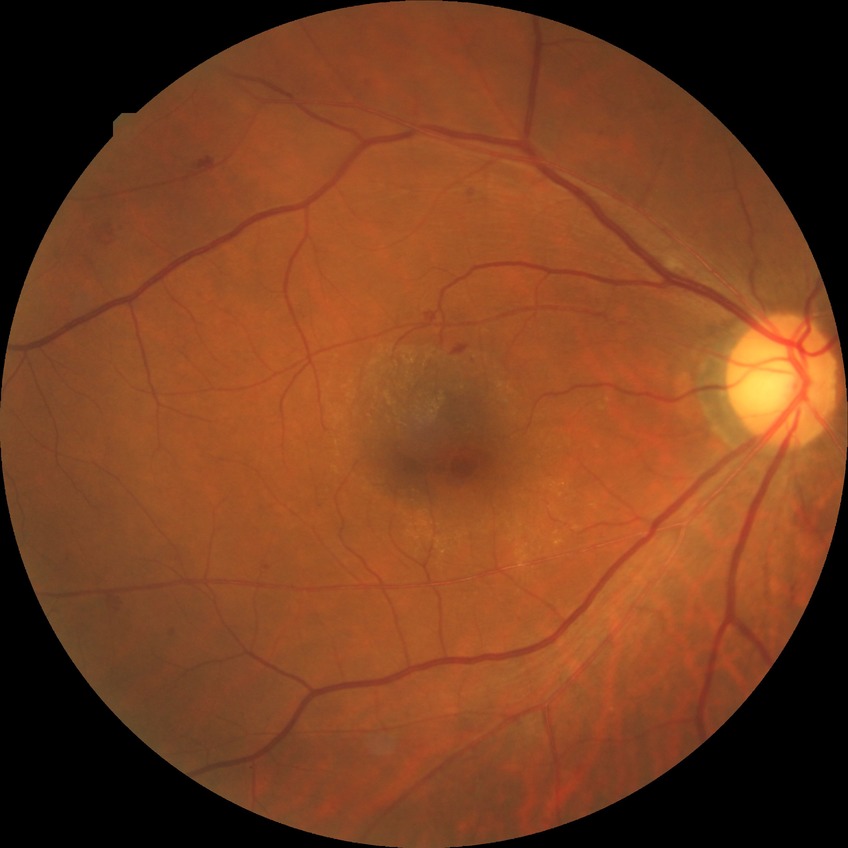

The retinopathy is classified as non-proliferative diabetic retinopathy. Diabetic retinopathy (DR) is simple diabetic retinopathy (SDR).